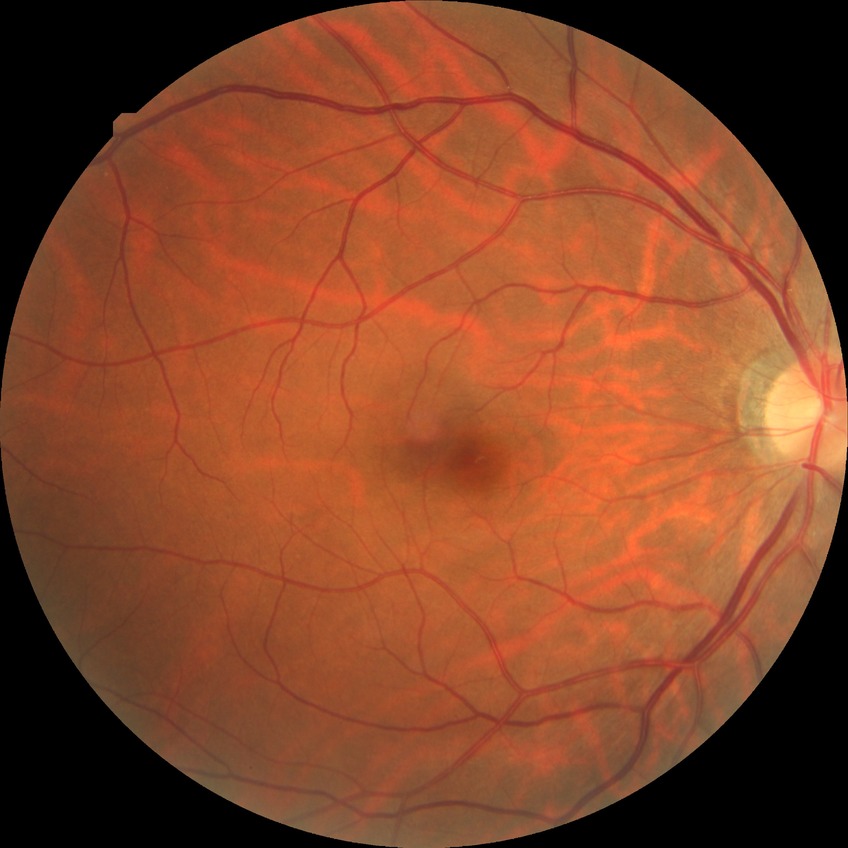

modified Davis classification = no diabetic retinopathy.